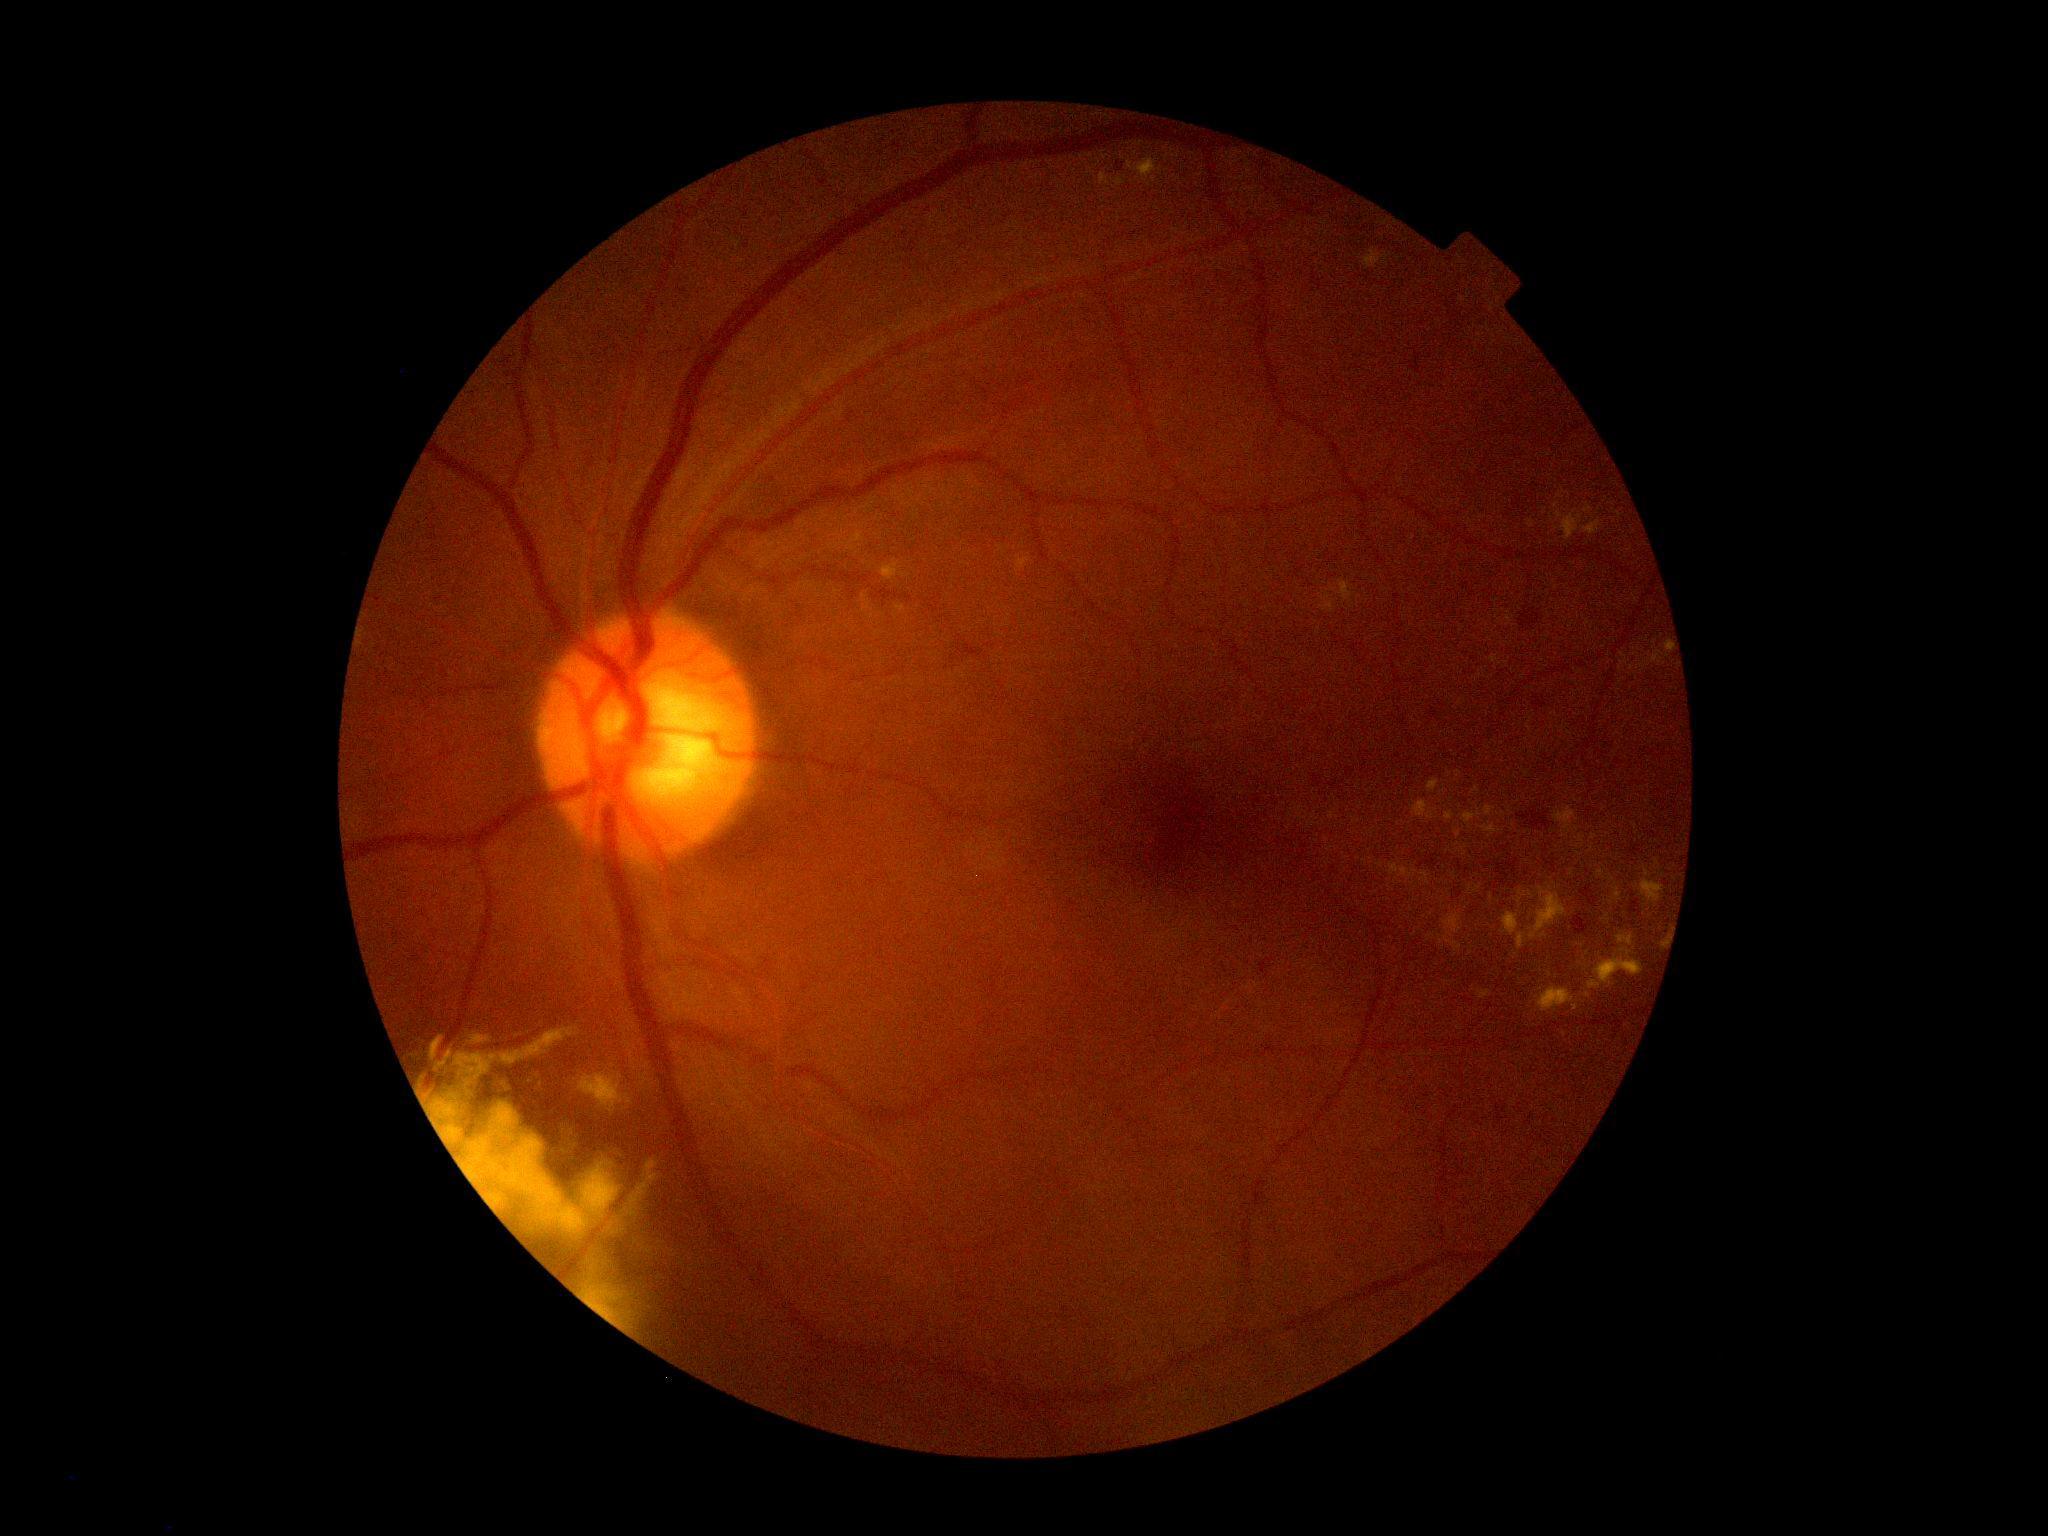

partial: true
dr_grade: 2
lesions:
  ex:
    - <box>1454,830,1461,838</box>
    - <box>1428,779,1440,793</box>
    - <box>1588,949,1644,990</box>
    - <box>1388,863,1419,879</box>
    - <box>1535,987,1575,1012</box>
    - <box>1609,887,1622,905</box>
    - <box>1443,914,1462,951</box>
    - <box>1017,553,1034,571</box>
    - <box>1484,806,1496,817</box>
    - <box>1439,936,1444,945</box>
  ex_small_approx:
    - x=1658 y=863
    - x=1454 y=876
    - x=1415 y=935
    - x=1465 y=849
    - x=1663 y=944
    - x=1635 y=826
    - x=1503 y=814